DR severity per modified Davis staging — 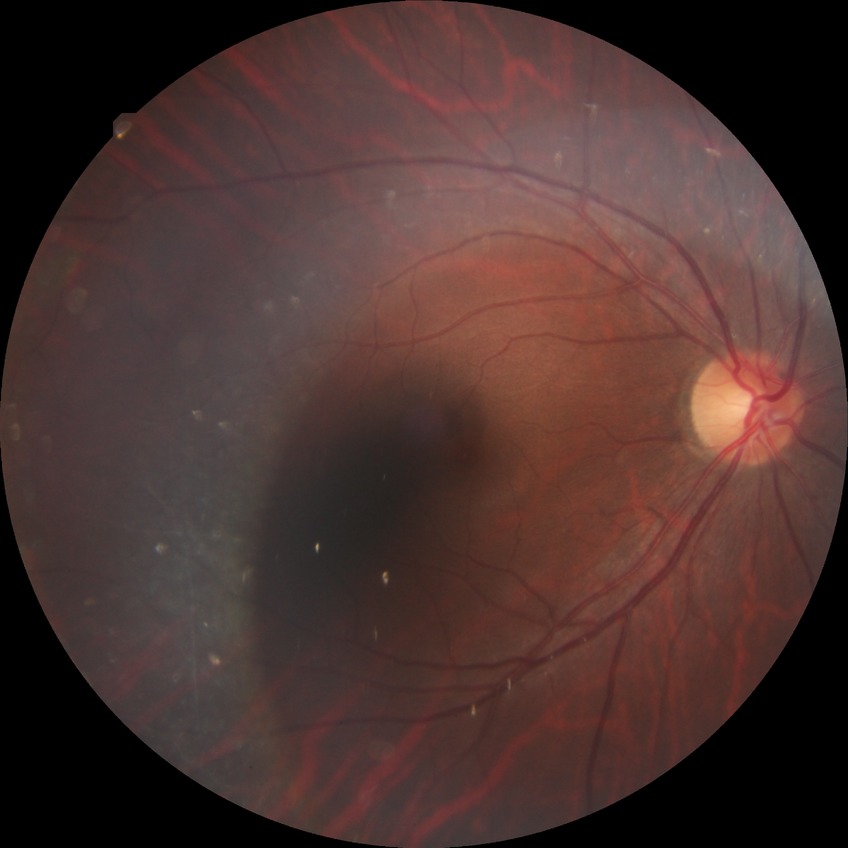

retinopathy stage: no diabetic retinopathy.